Color fundus photograph; 2102 x 1736 pixels: 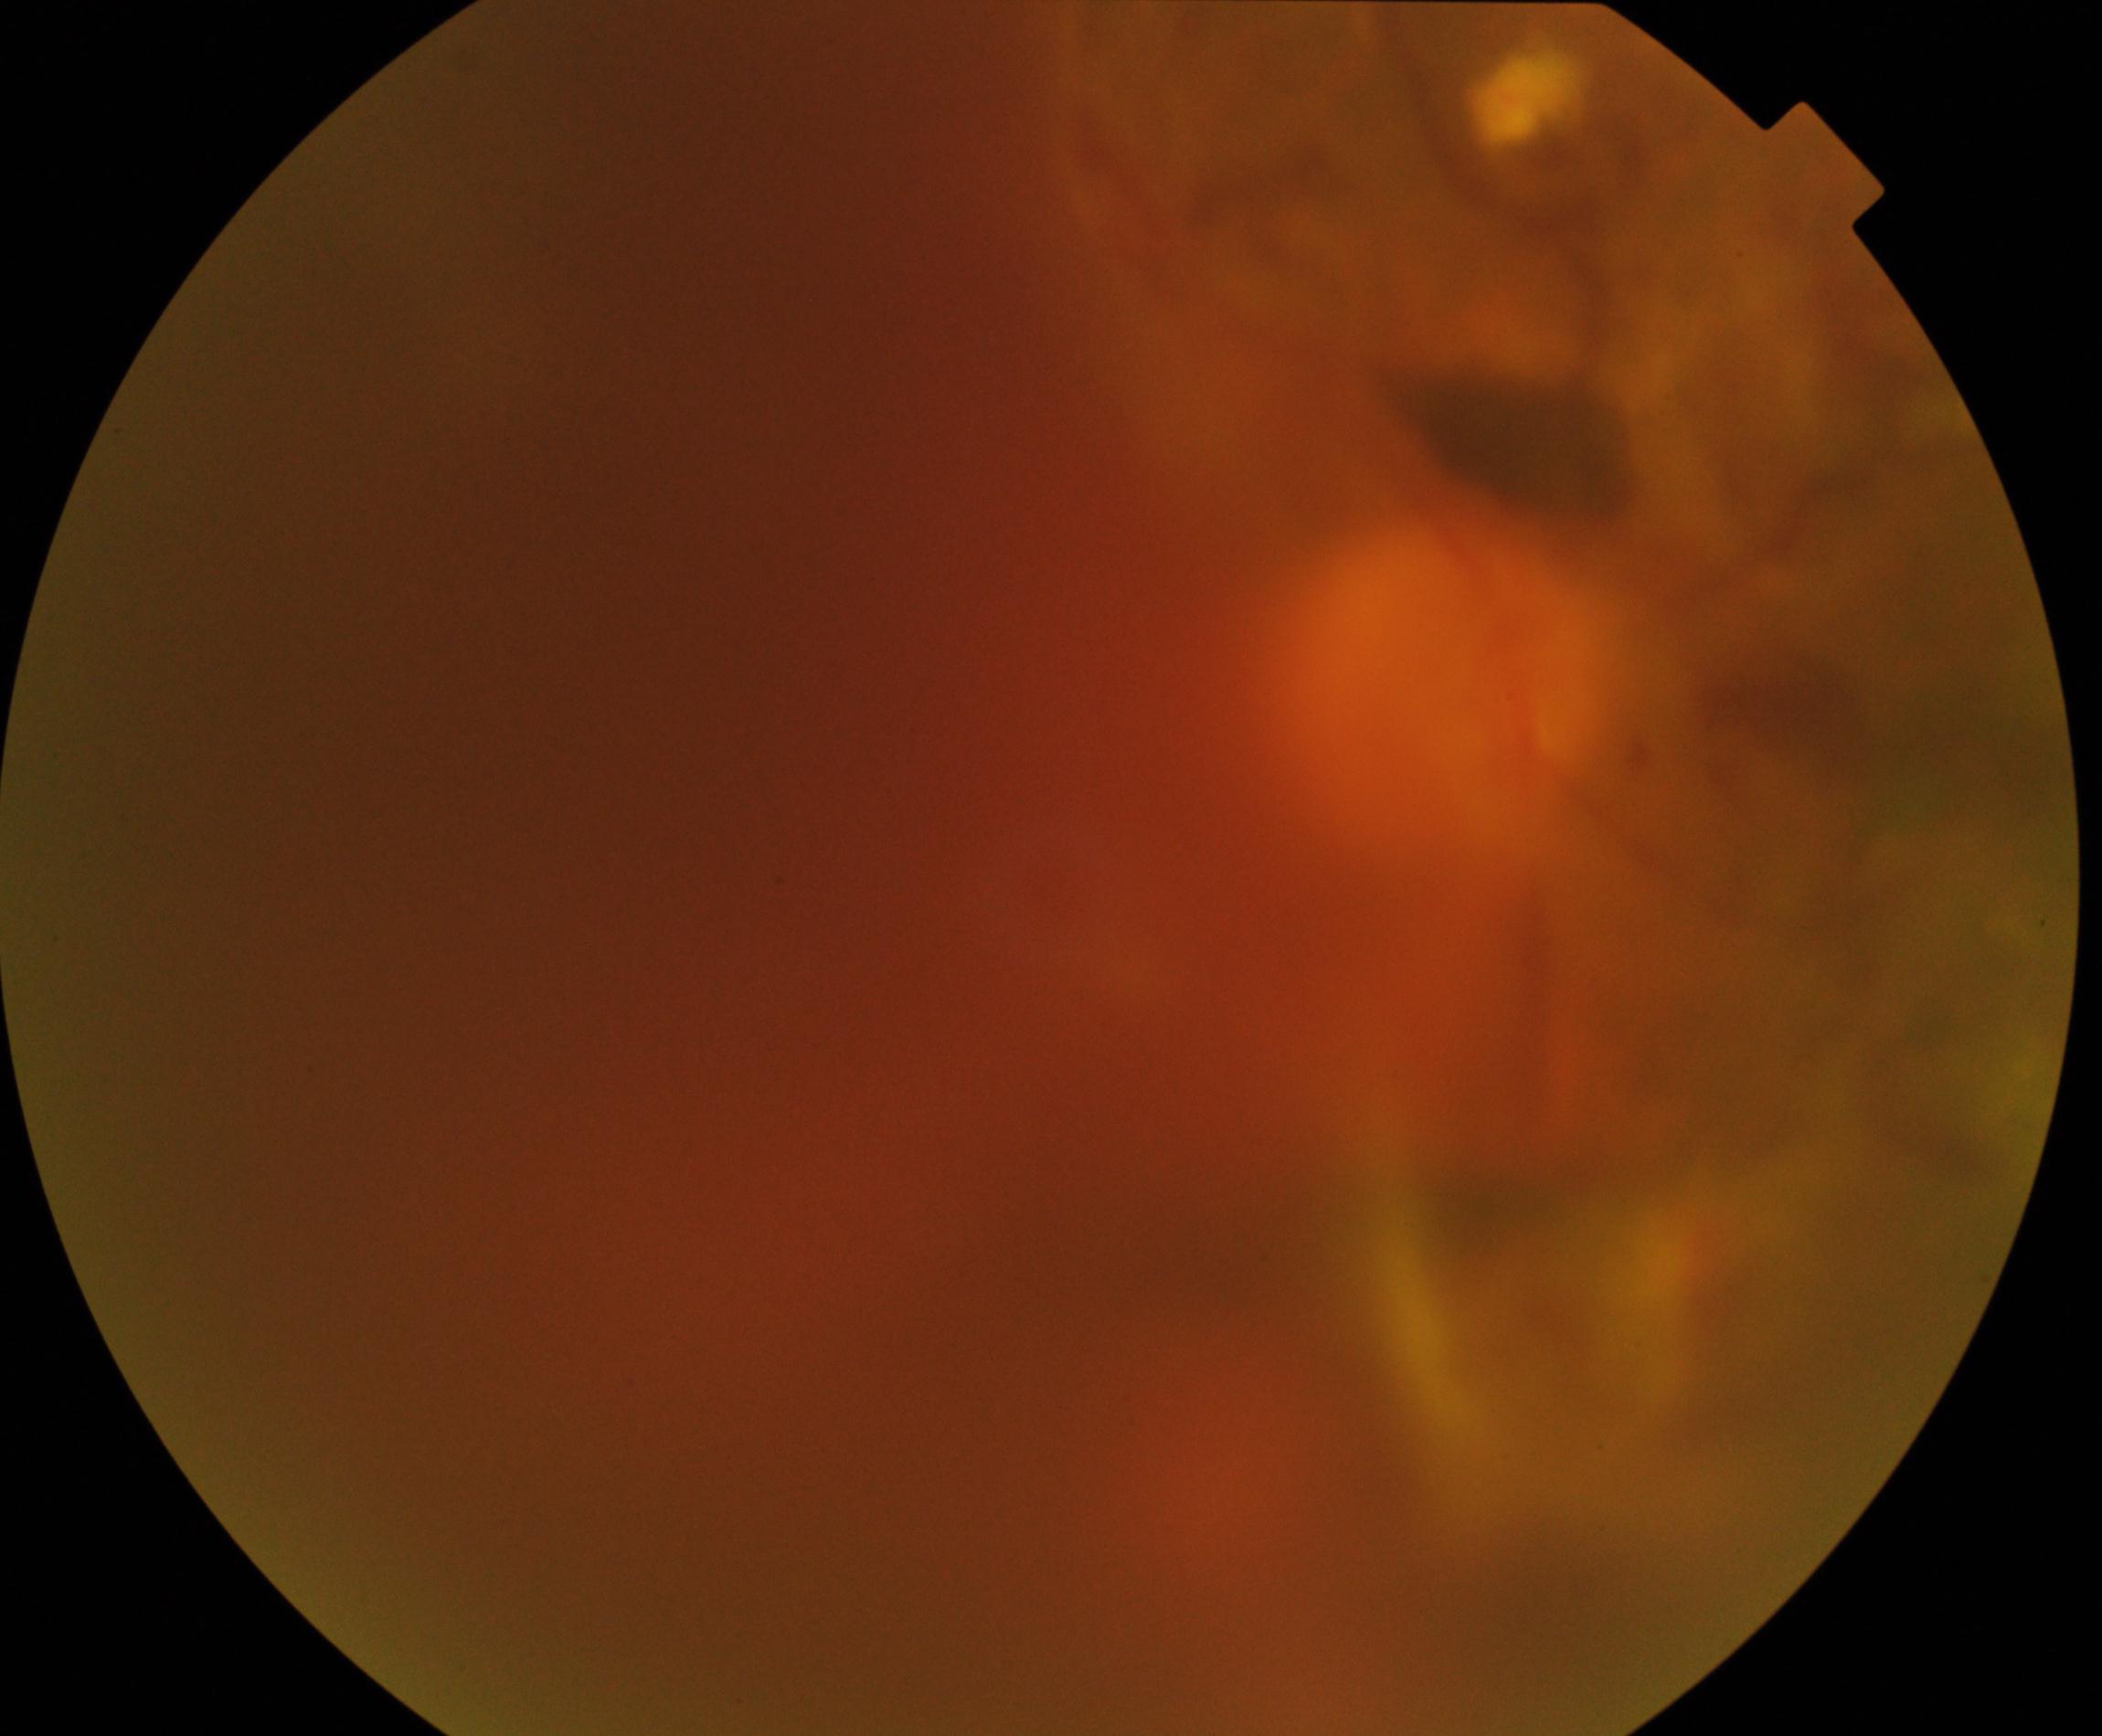 Image is blurred; retinal landmarks are largely obscured. Proliferative diabetic retinopathy is suspected.